Retinal fundus photograph:
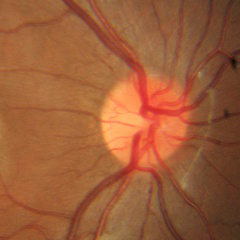 Showing no glaucomatous changes.